No pharmacologic dilation, FOV: 45 degrees, modified Davis classification.
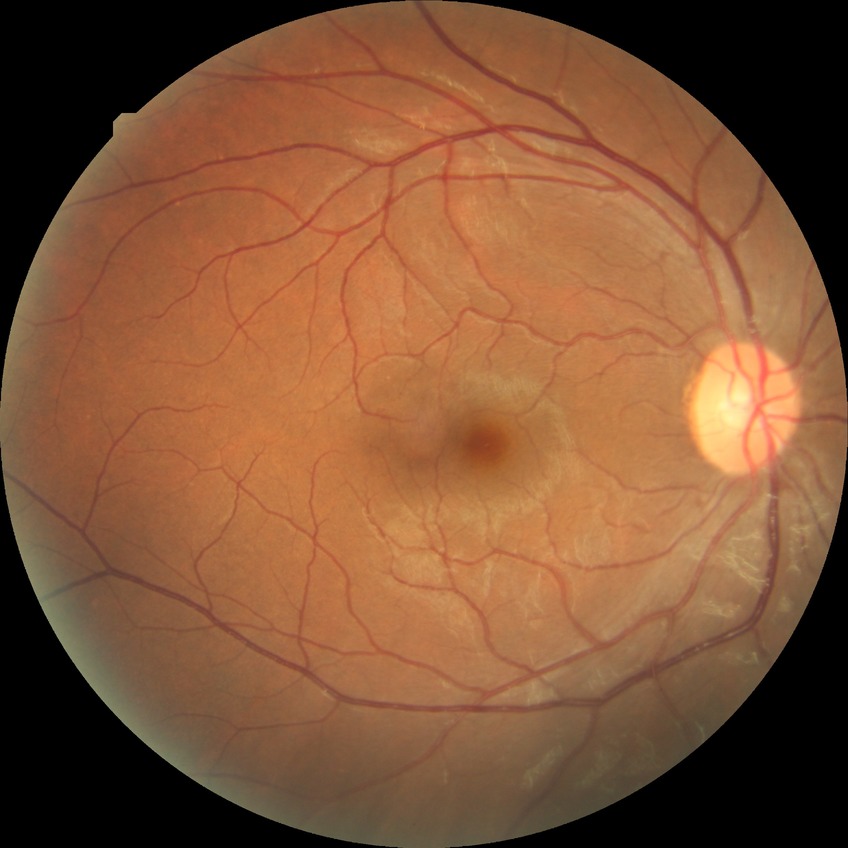 Davis stage = NDR; DR impression = negative for DR.